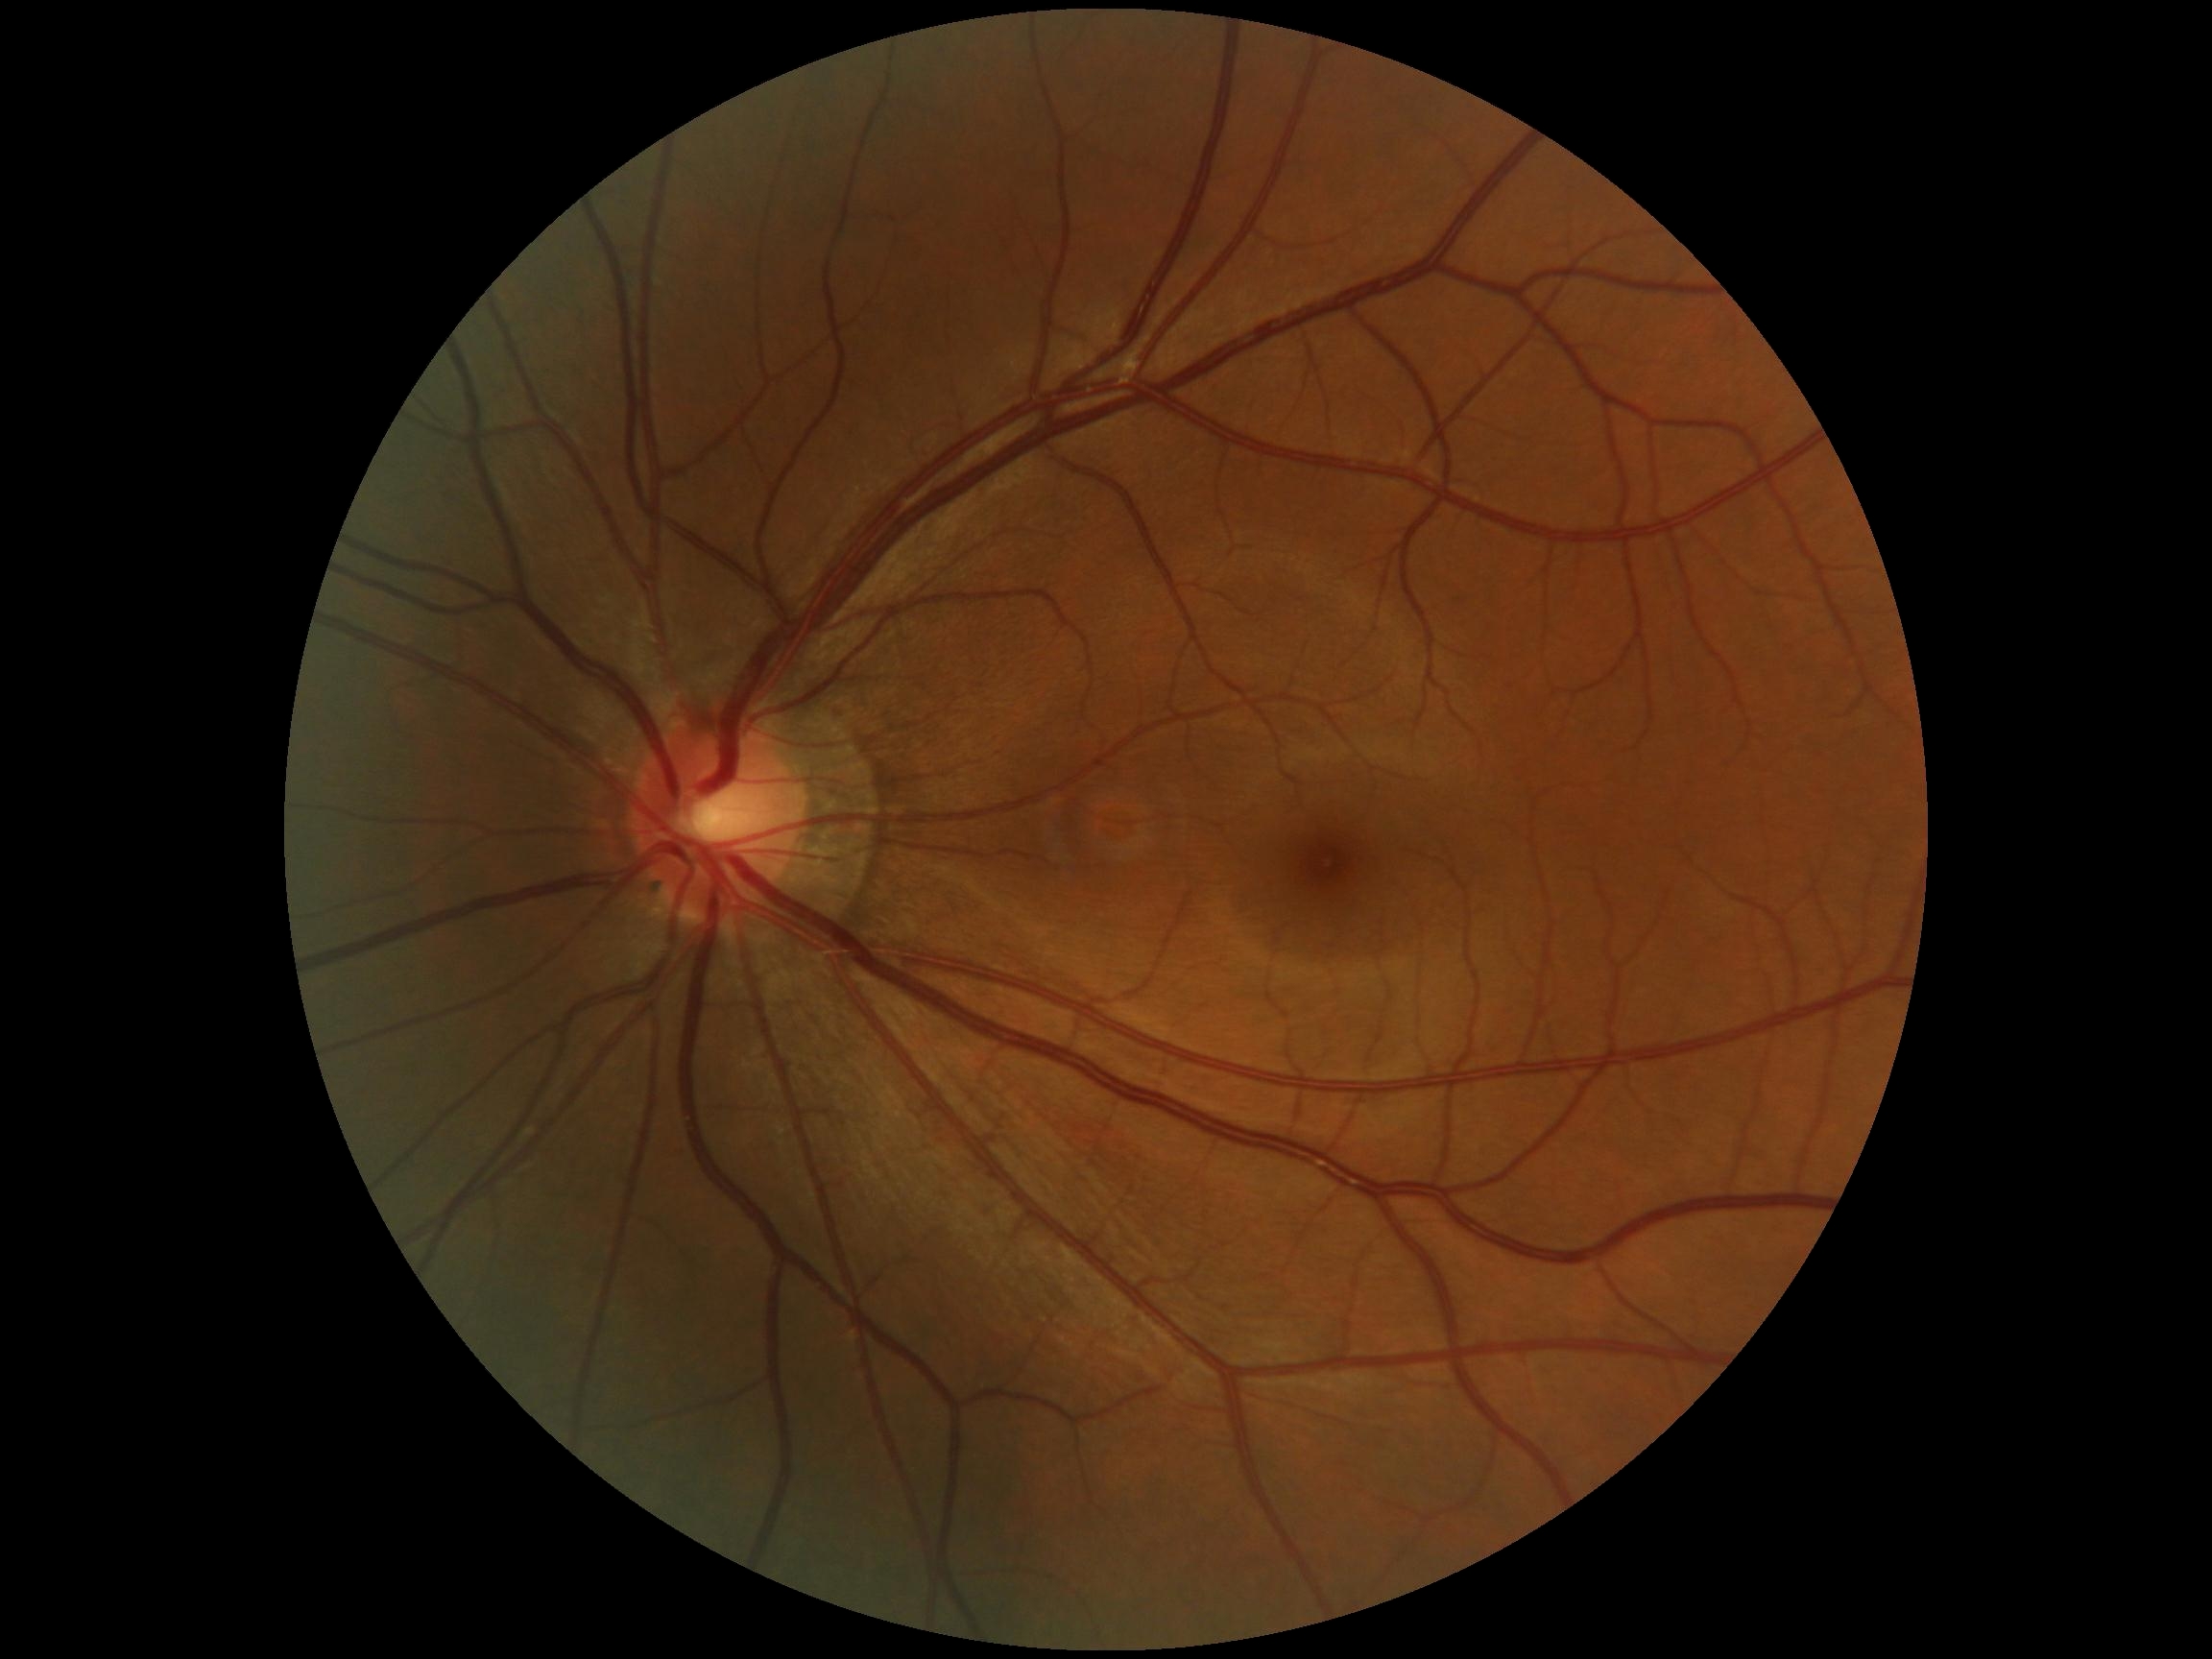
DR is grade 0.